1440x1080px. Acquired on the Natus RetCam Envision. Infant wide-field fundus photograph:
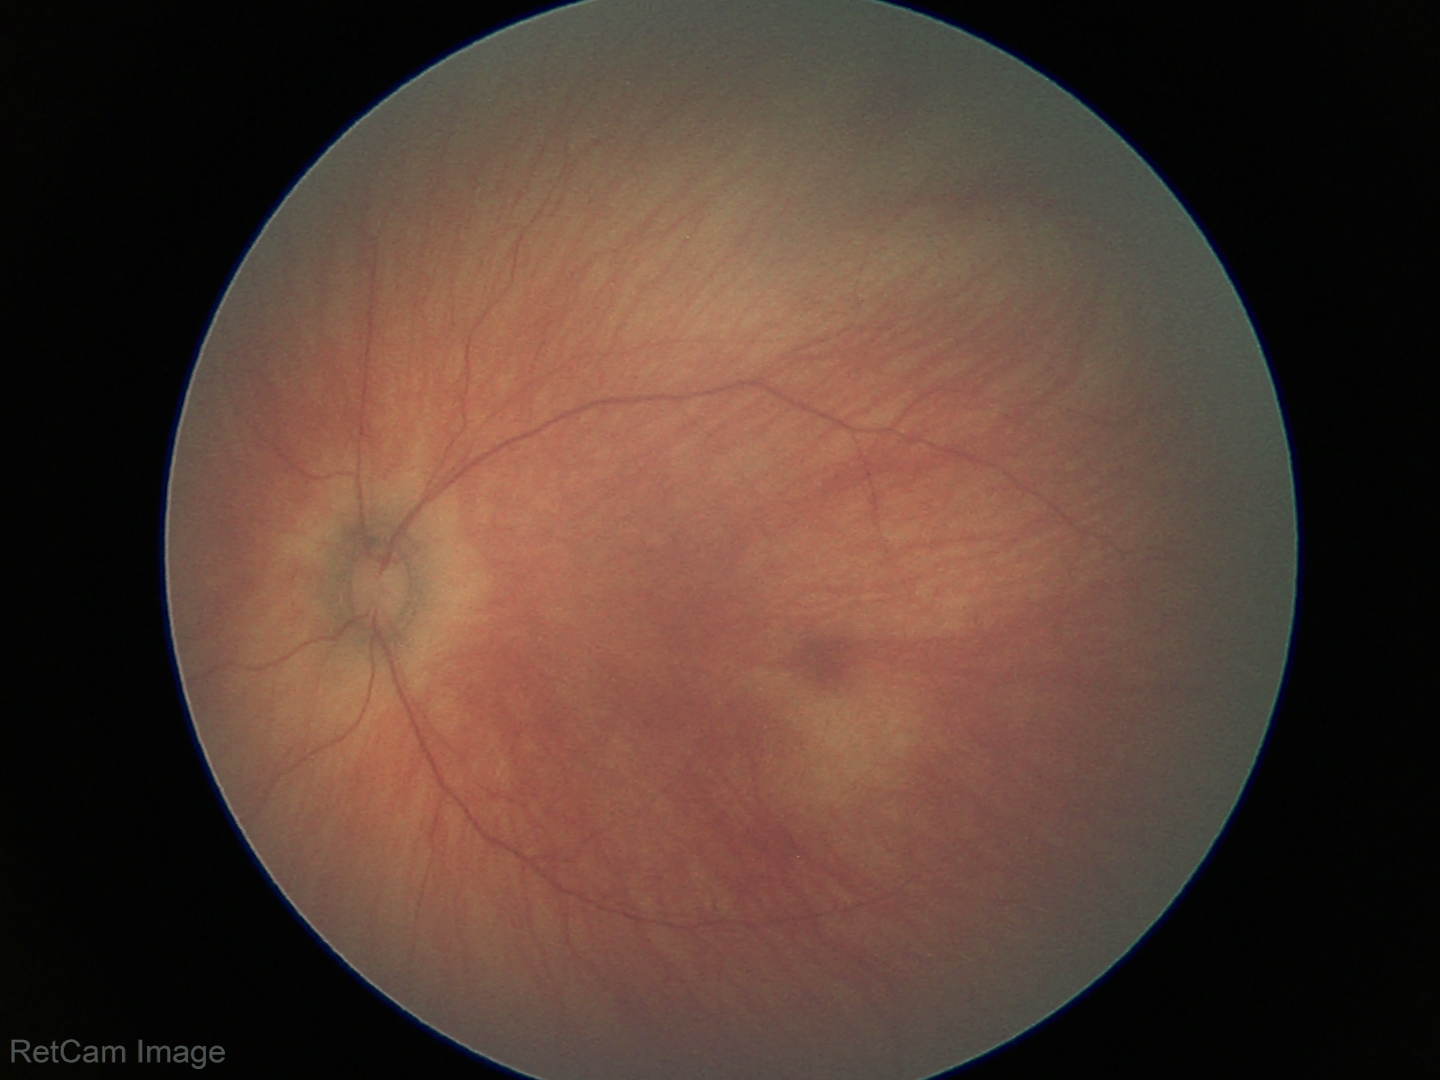

Normal screening examination.